Wide-field contact fundus photograph of an infant · image size 640x480
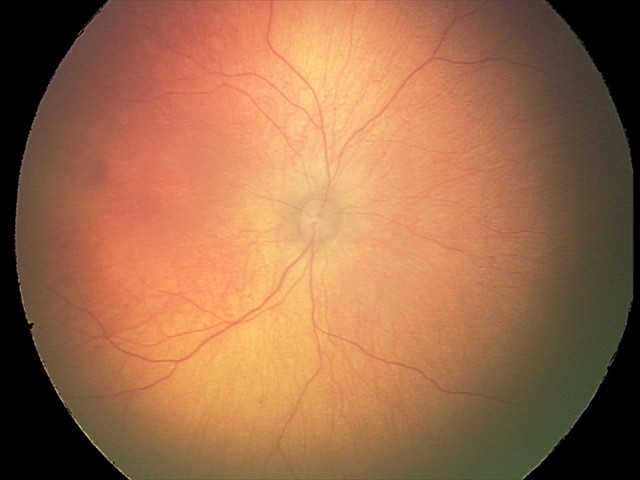

Examination with physiological retinal findings.